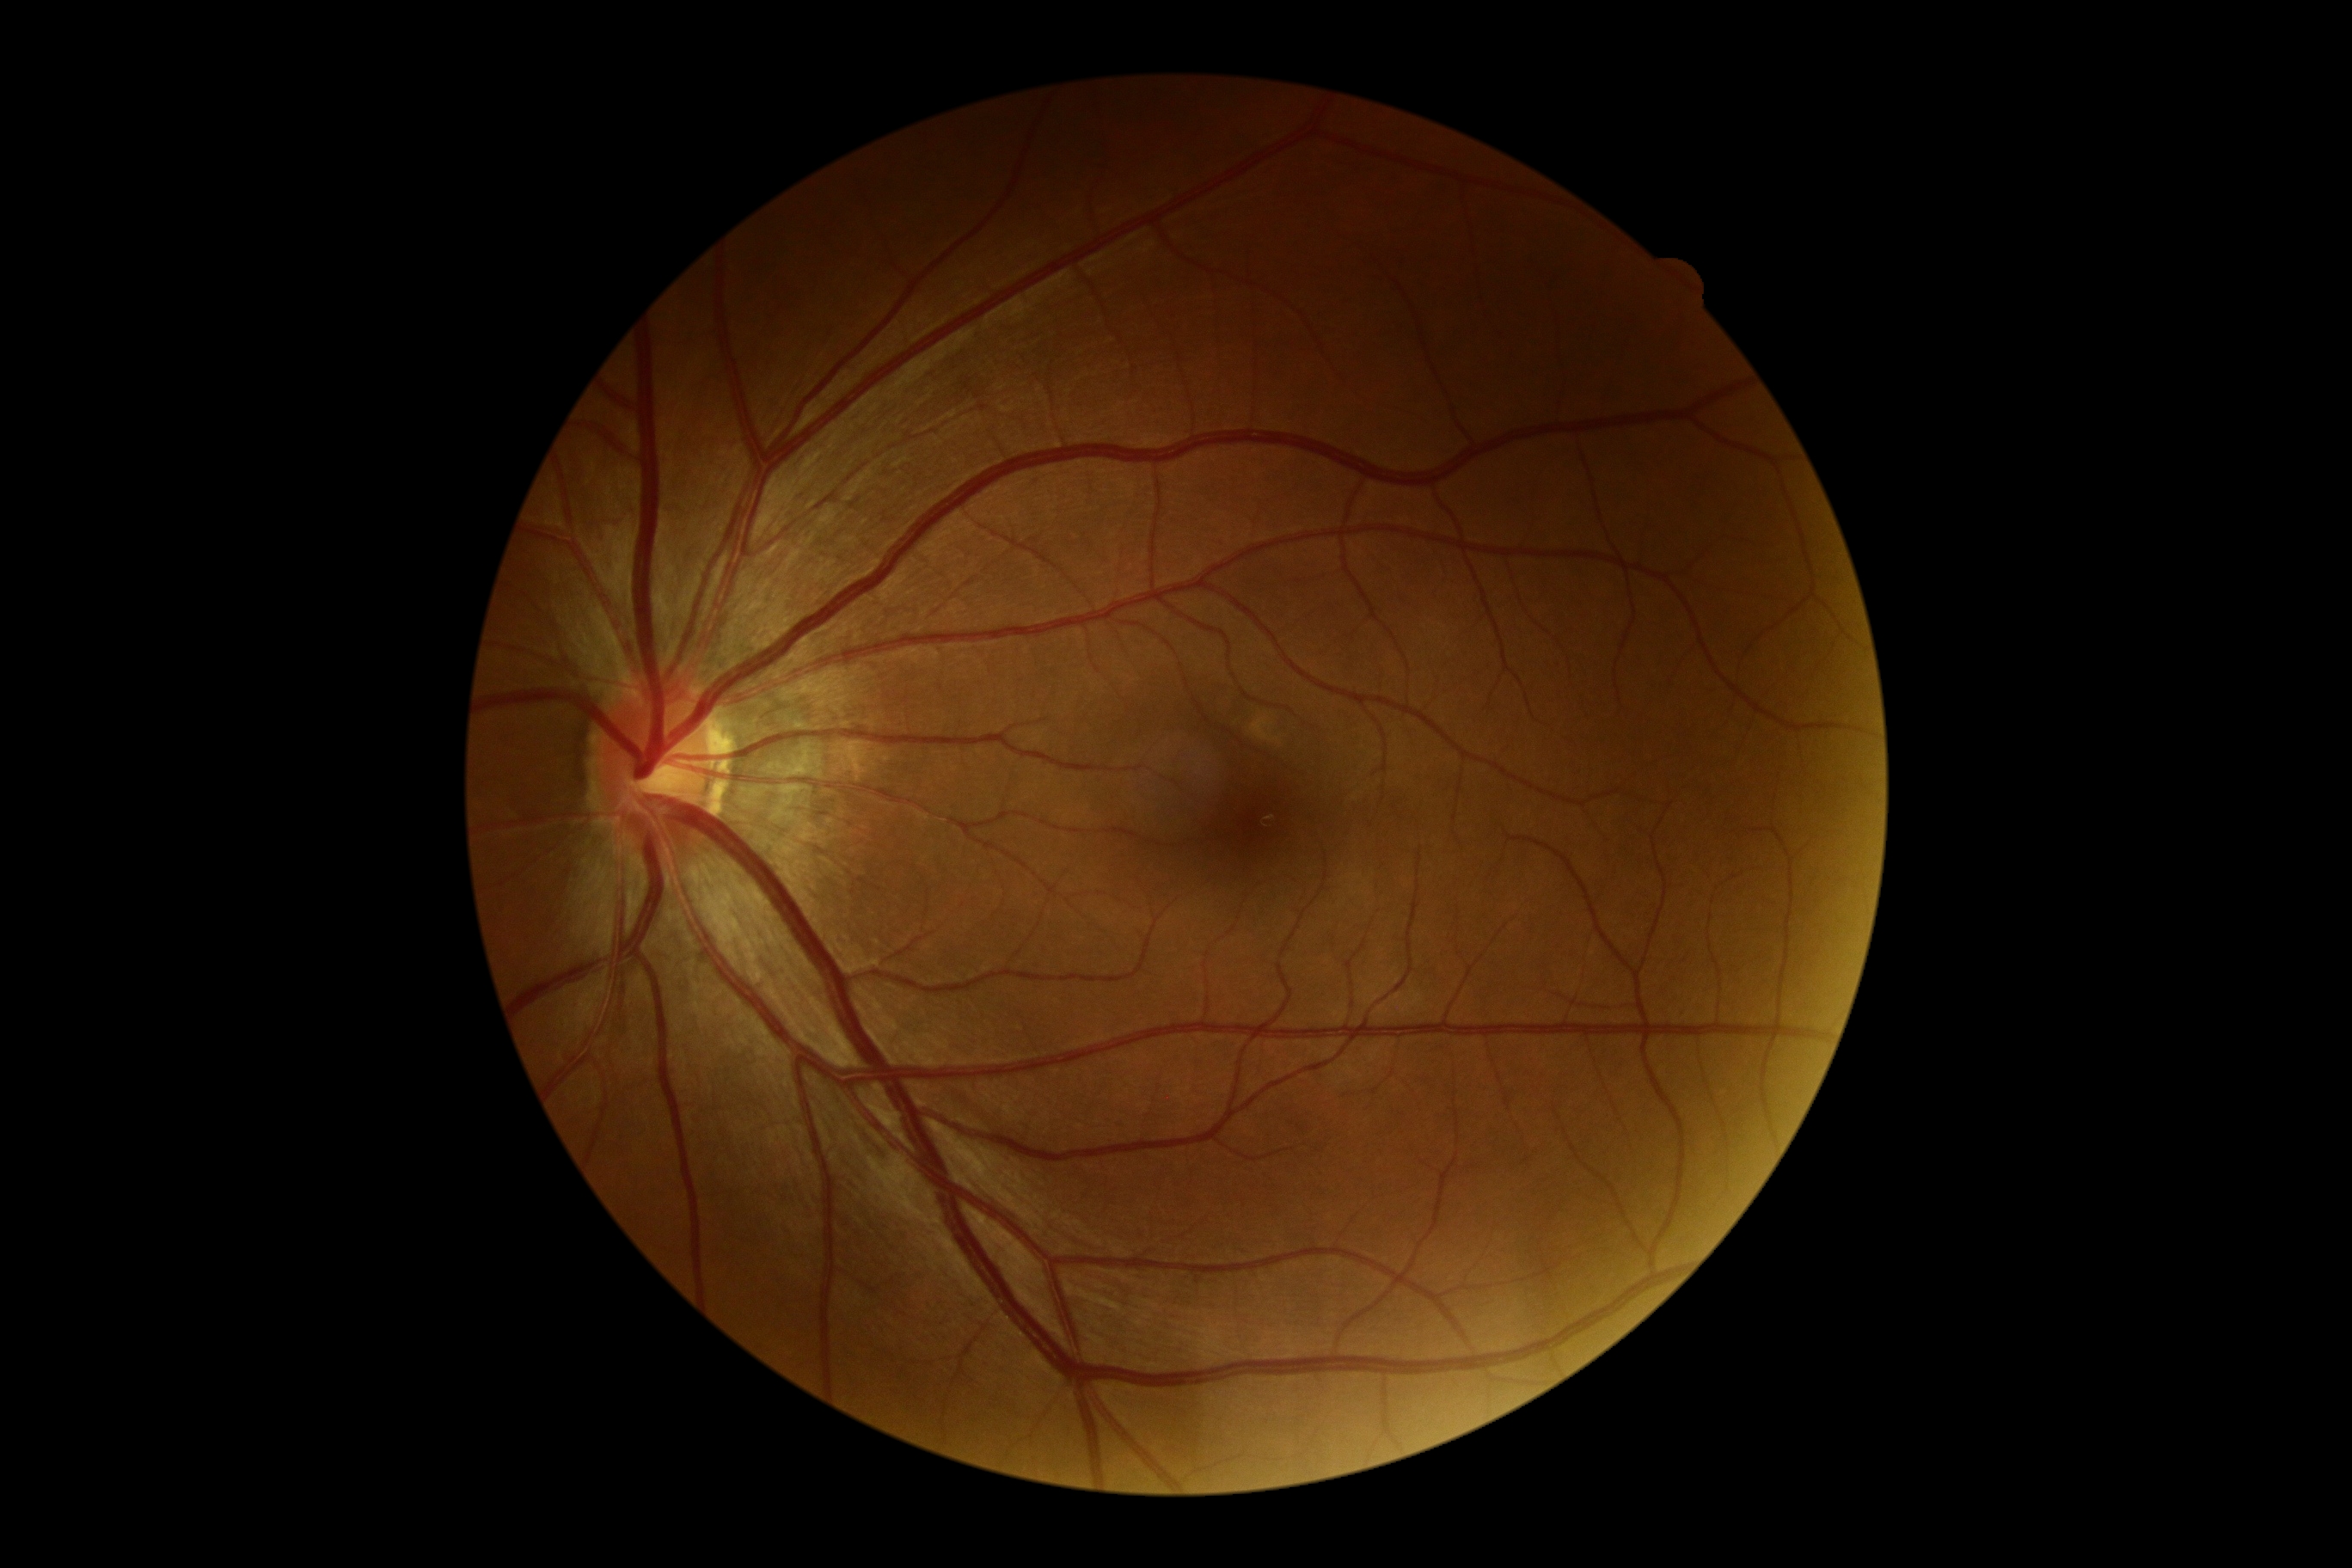
DR: grade 0 (no apparent retinopathy) — no visible signs of diabetic retinopathy. No apparent diabetic retinopathy.